Retinal fundus photograph · 735x707.
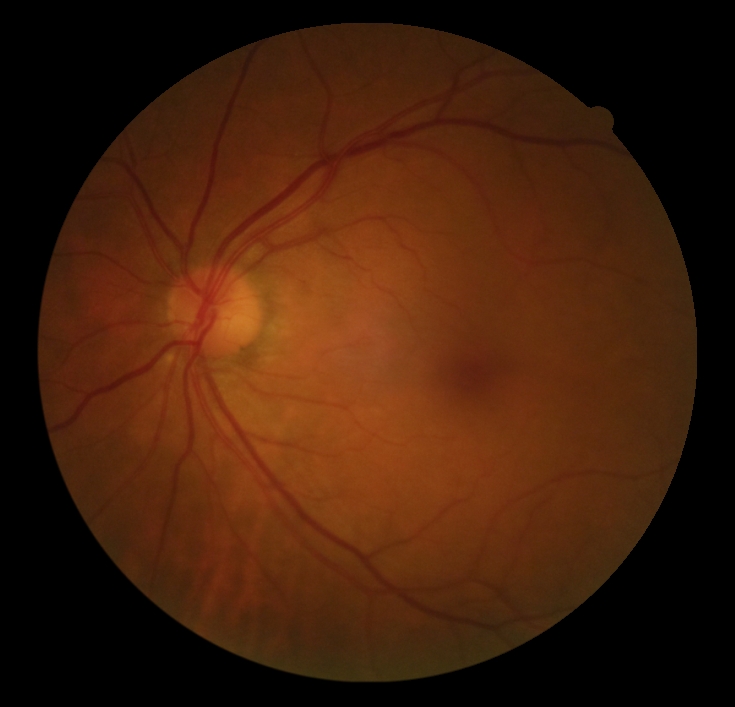 No diabetic retinal disease findings.
DR is grade 0 (no apparent retinopathy).